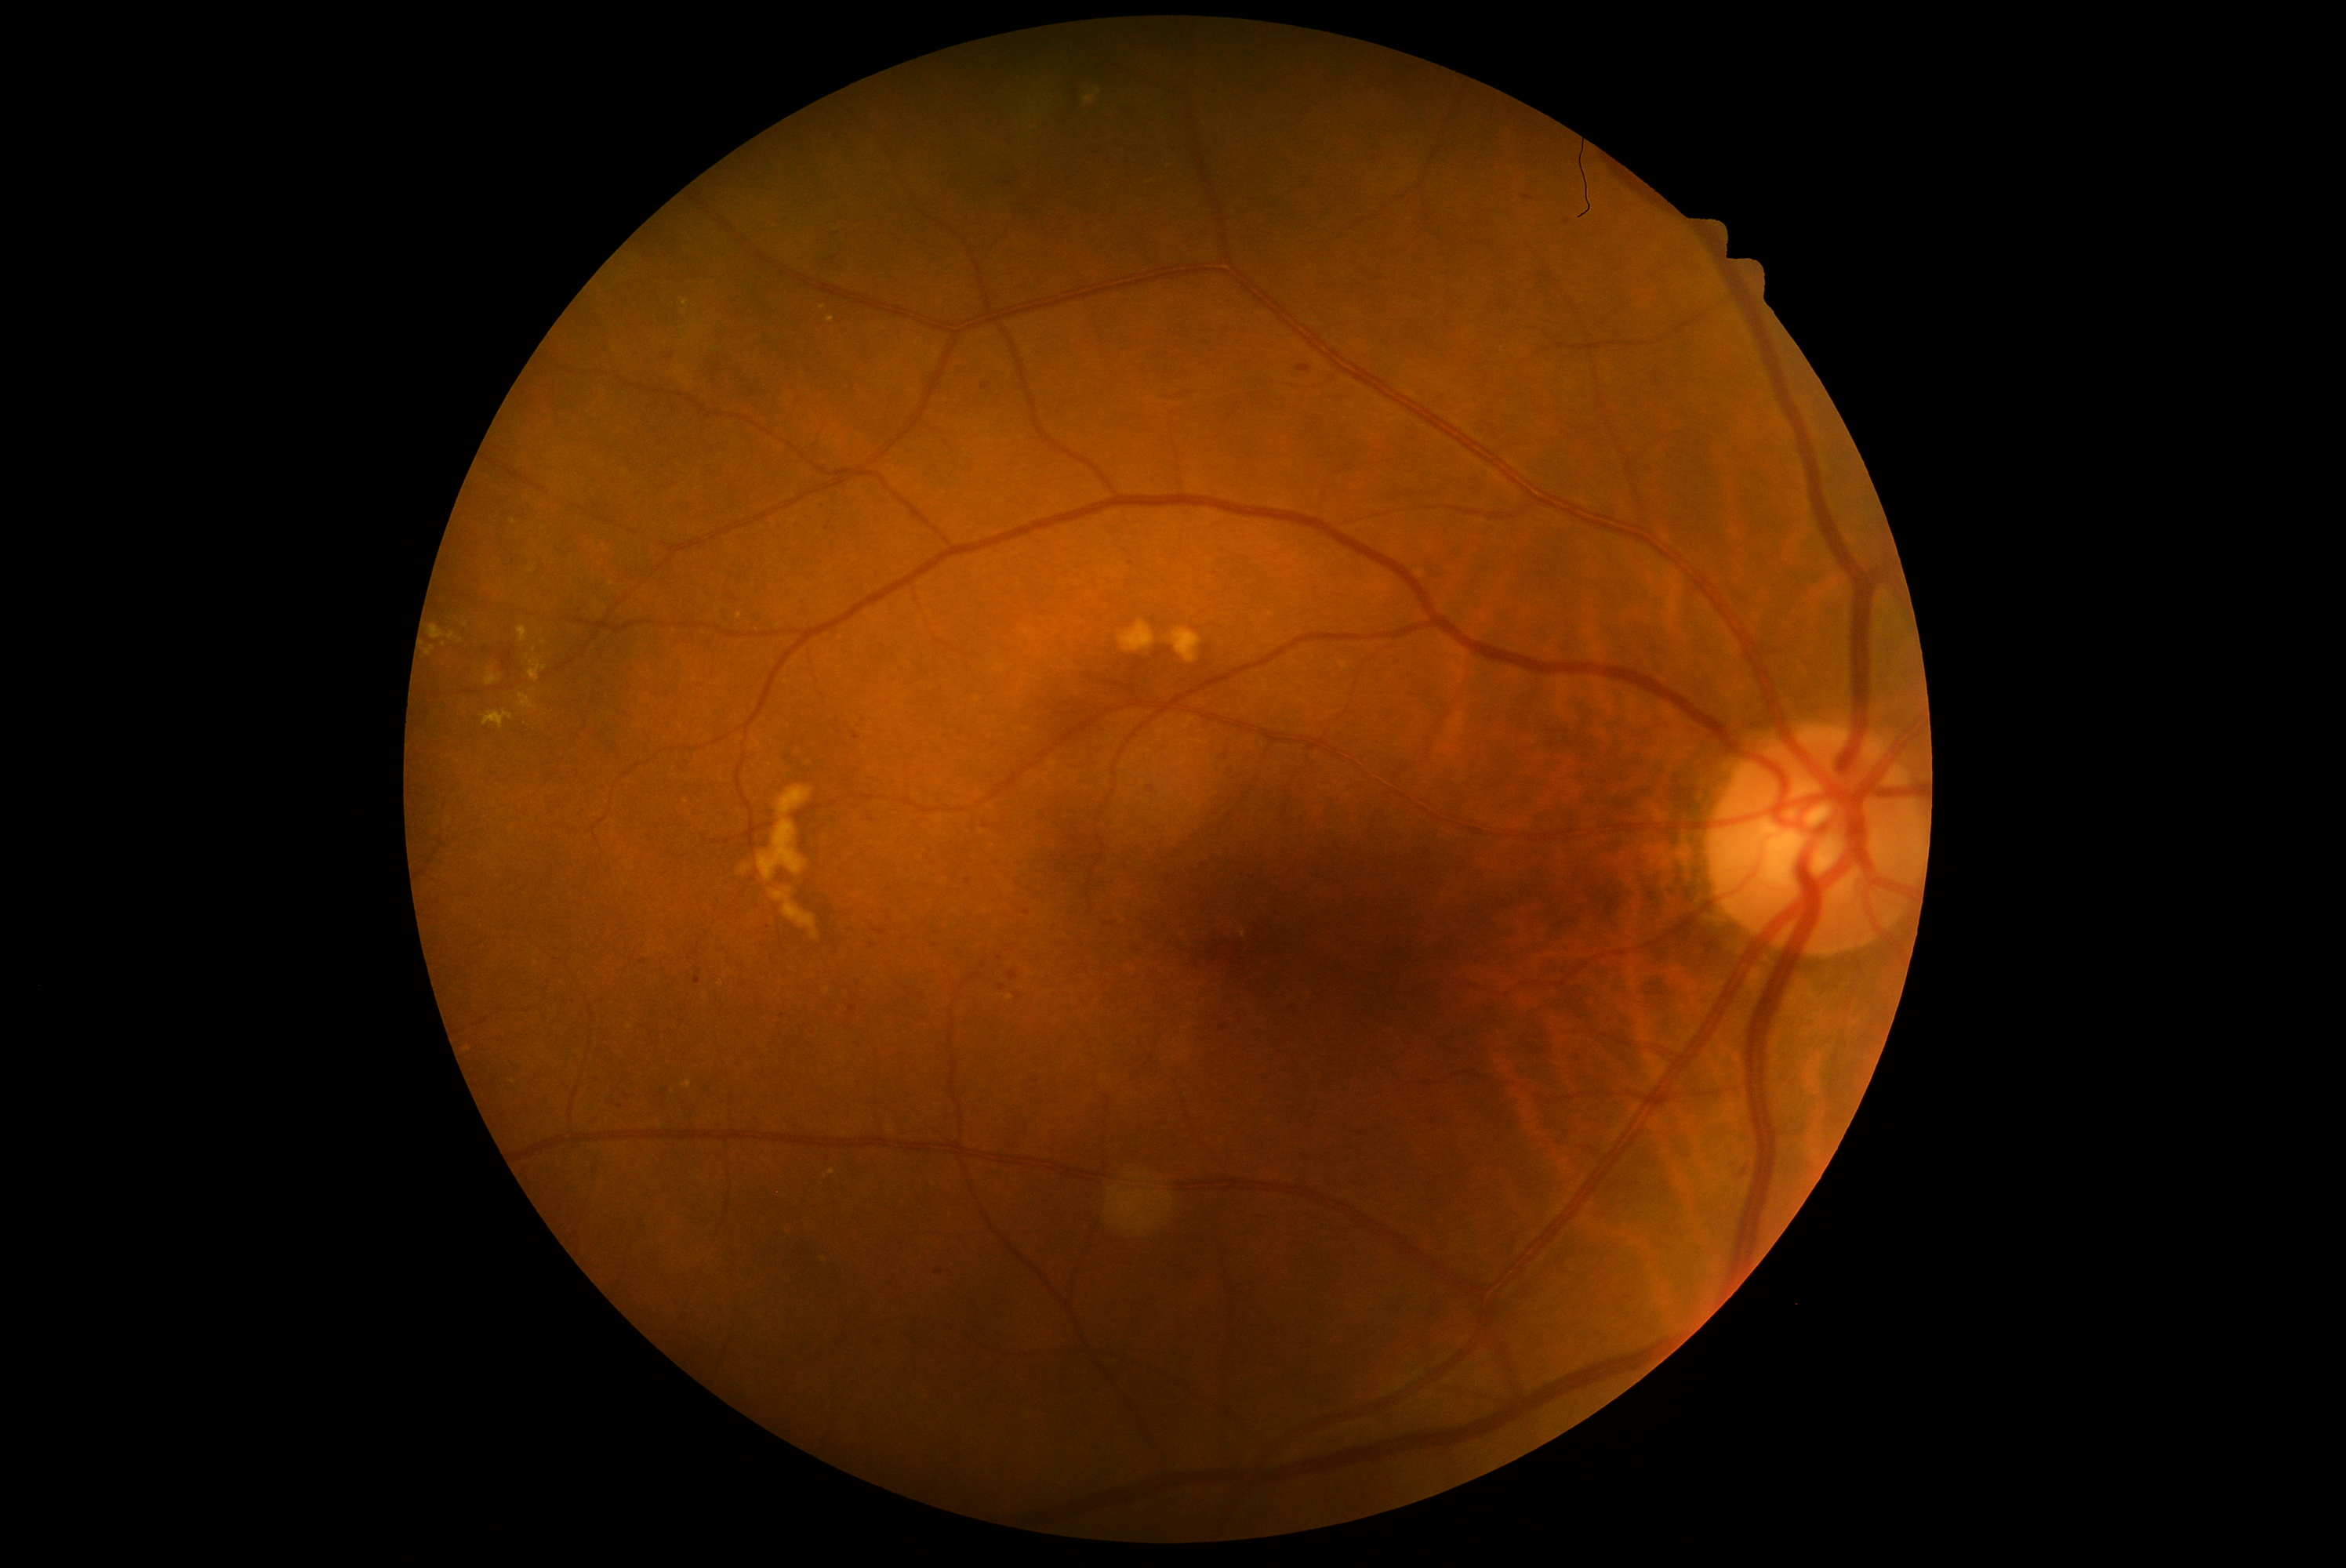 <lesions partial="true">
  <dr_grade>2</dr_grade>
  <he partial="true">782 216 791 223; 498 639 506 647; 503 647 515 670; 981 385 989 391; 1008 971 1019 981; 1163 388 1200 402; 1008 269 1017 278; 1006 131 1019 148; 1296 365 1312 374</he>
  <he_small_approx>(938; 1272); (620; 1106); (786; 759); (986; 826); (783; 1016); (701; 787)</he_small_approx>
</lesions>